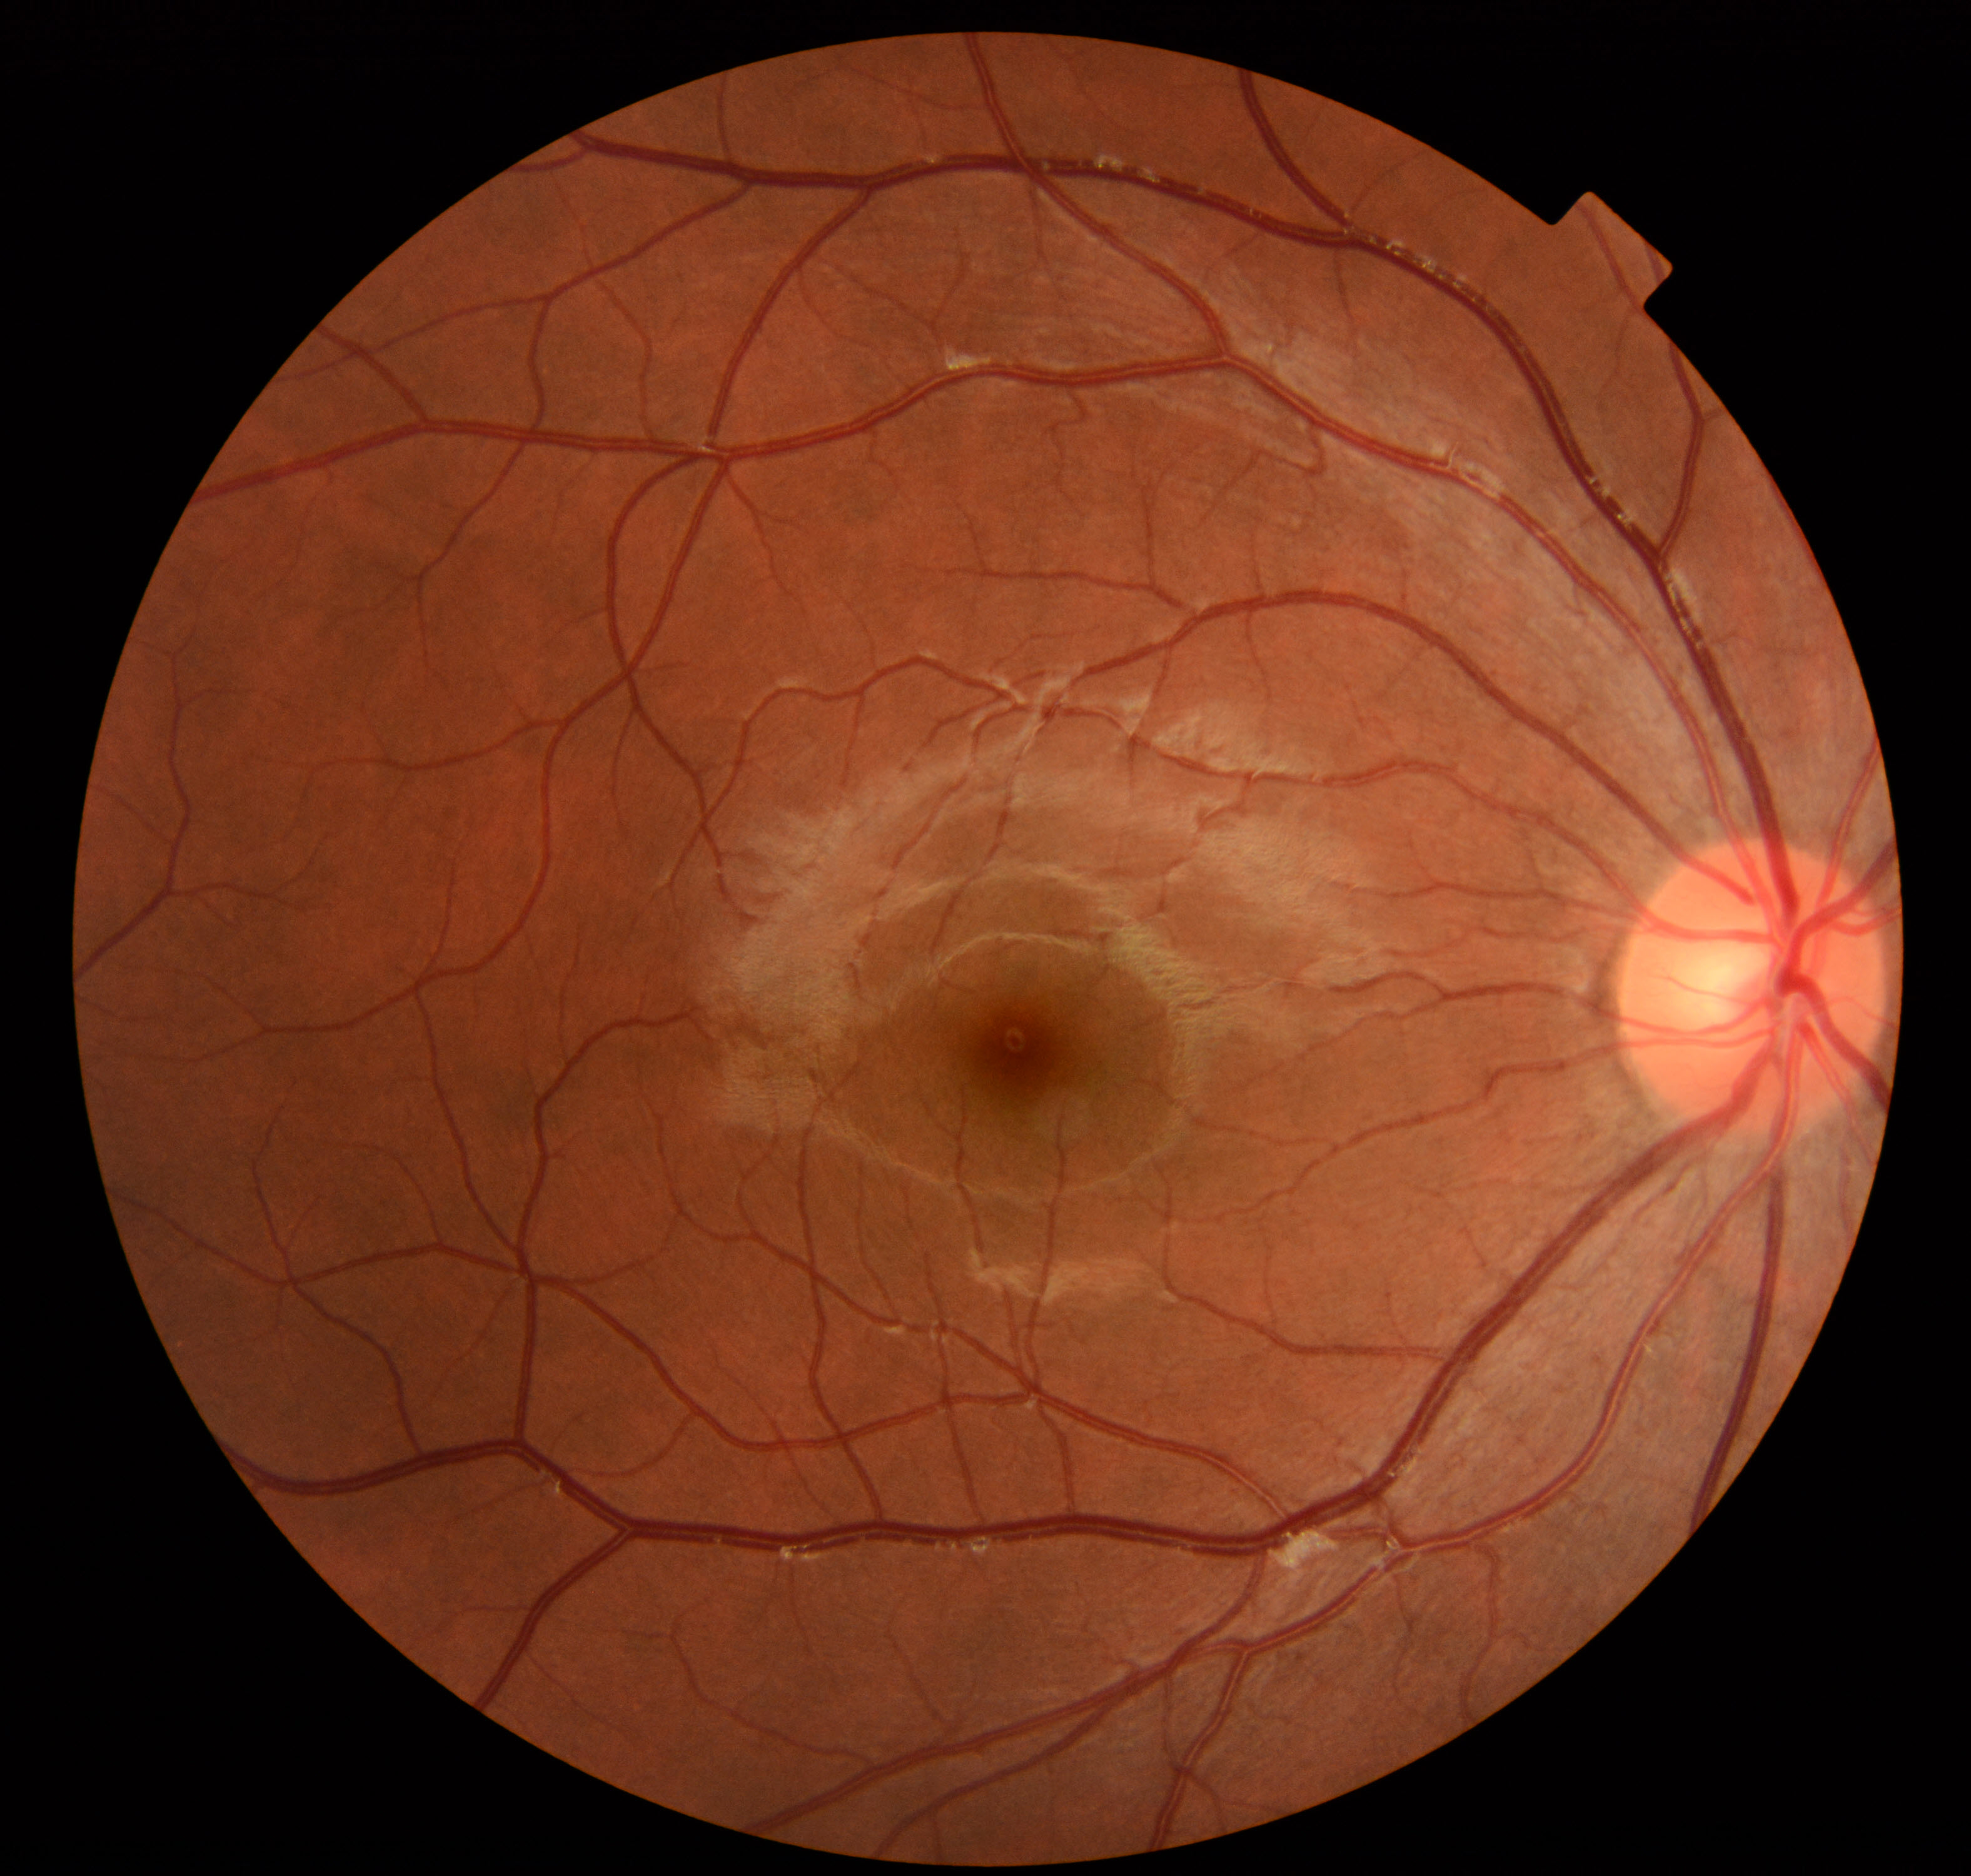

Impression: normal fundus.